45 degree fundus photograph — 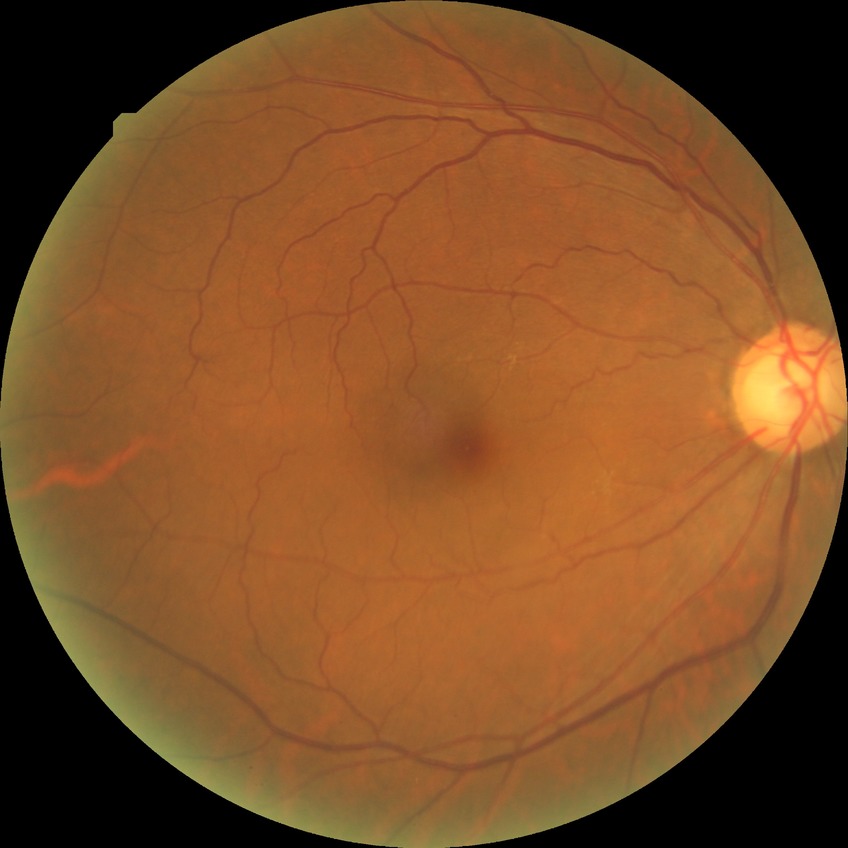

Modified Davis classification is simple diabetic retinopathy.